Portable fundus camera image:
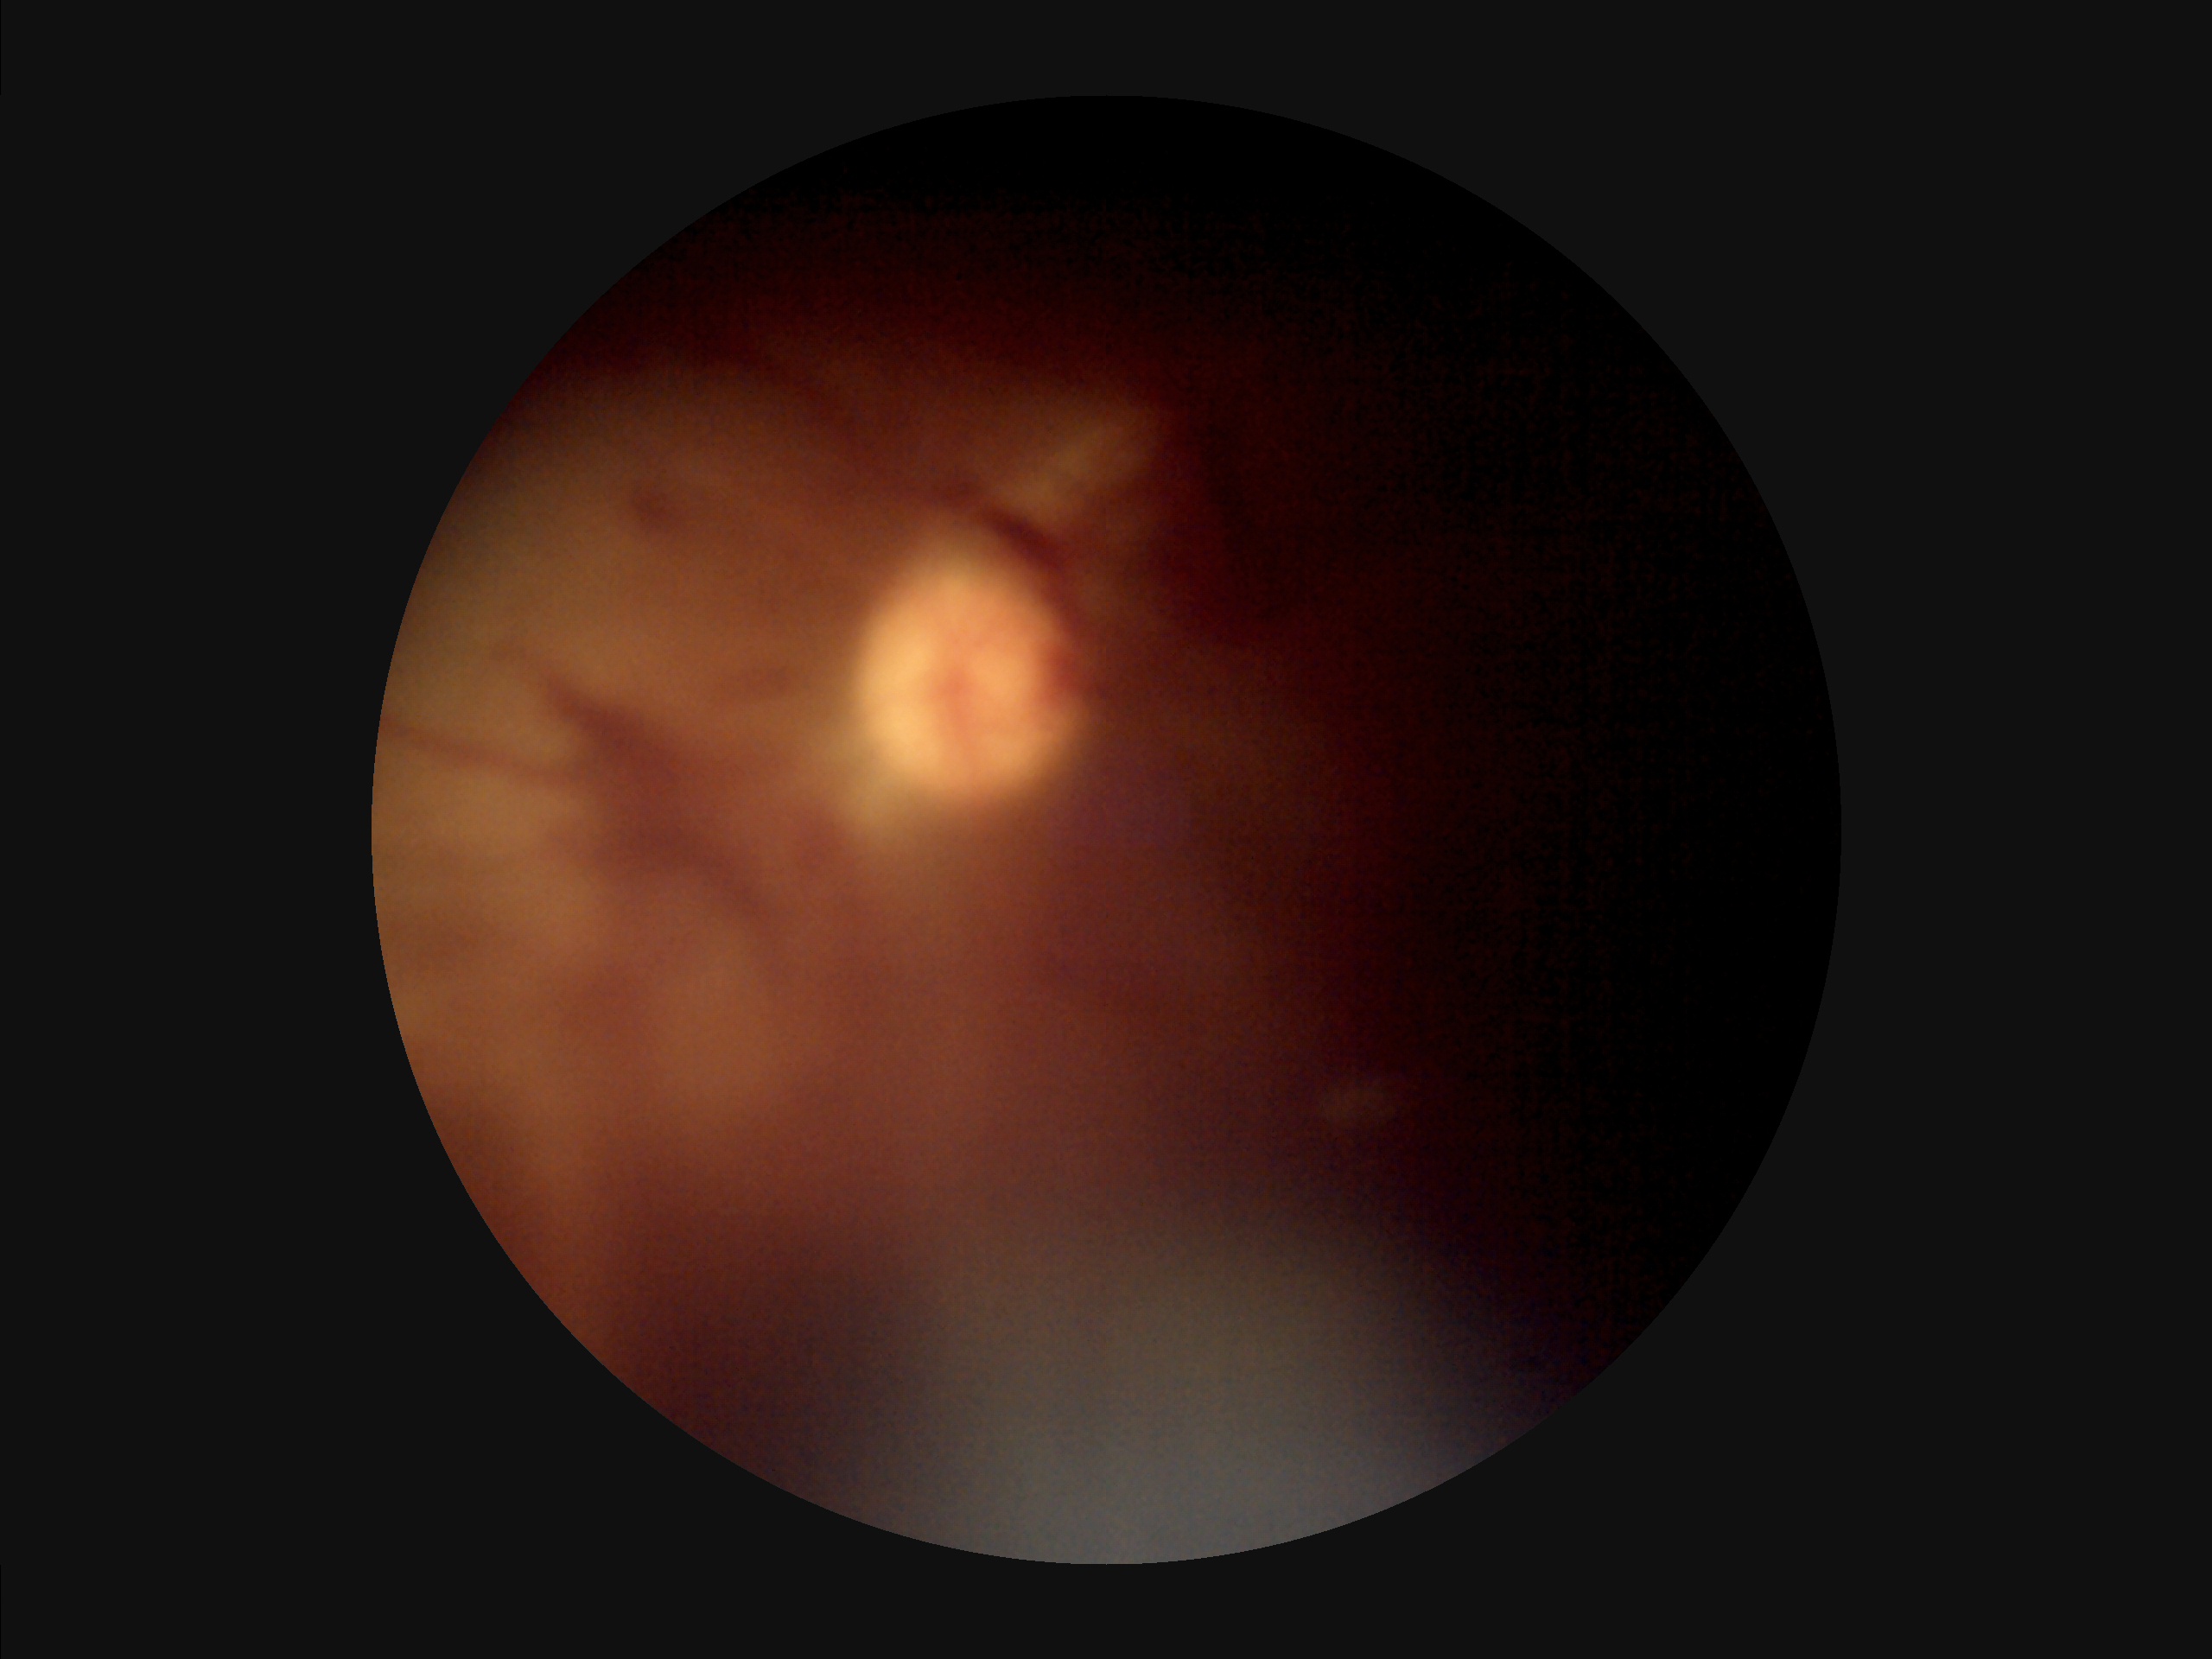 Narrow intensity range; structures are hard to distinguish.
Overall image quality is poor.
Illumination is uneven.
Reduced sharpness with visible blur.